Color fundus image — 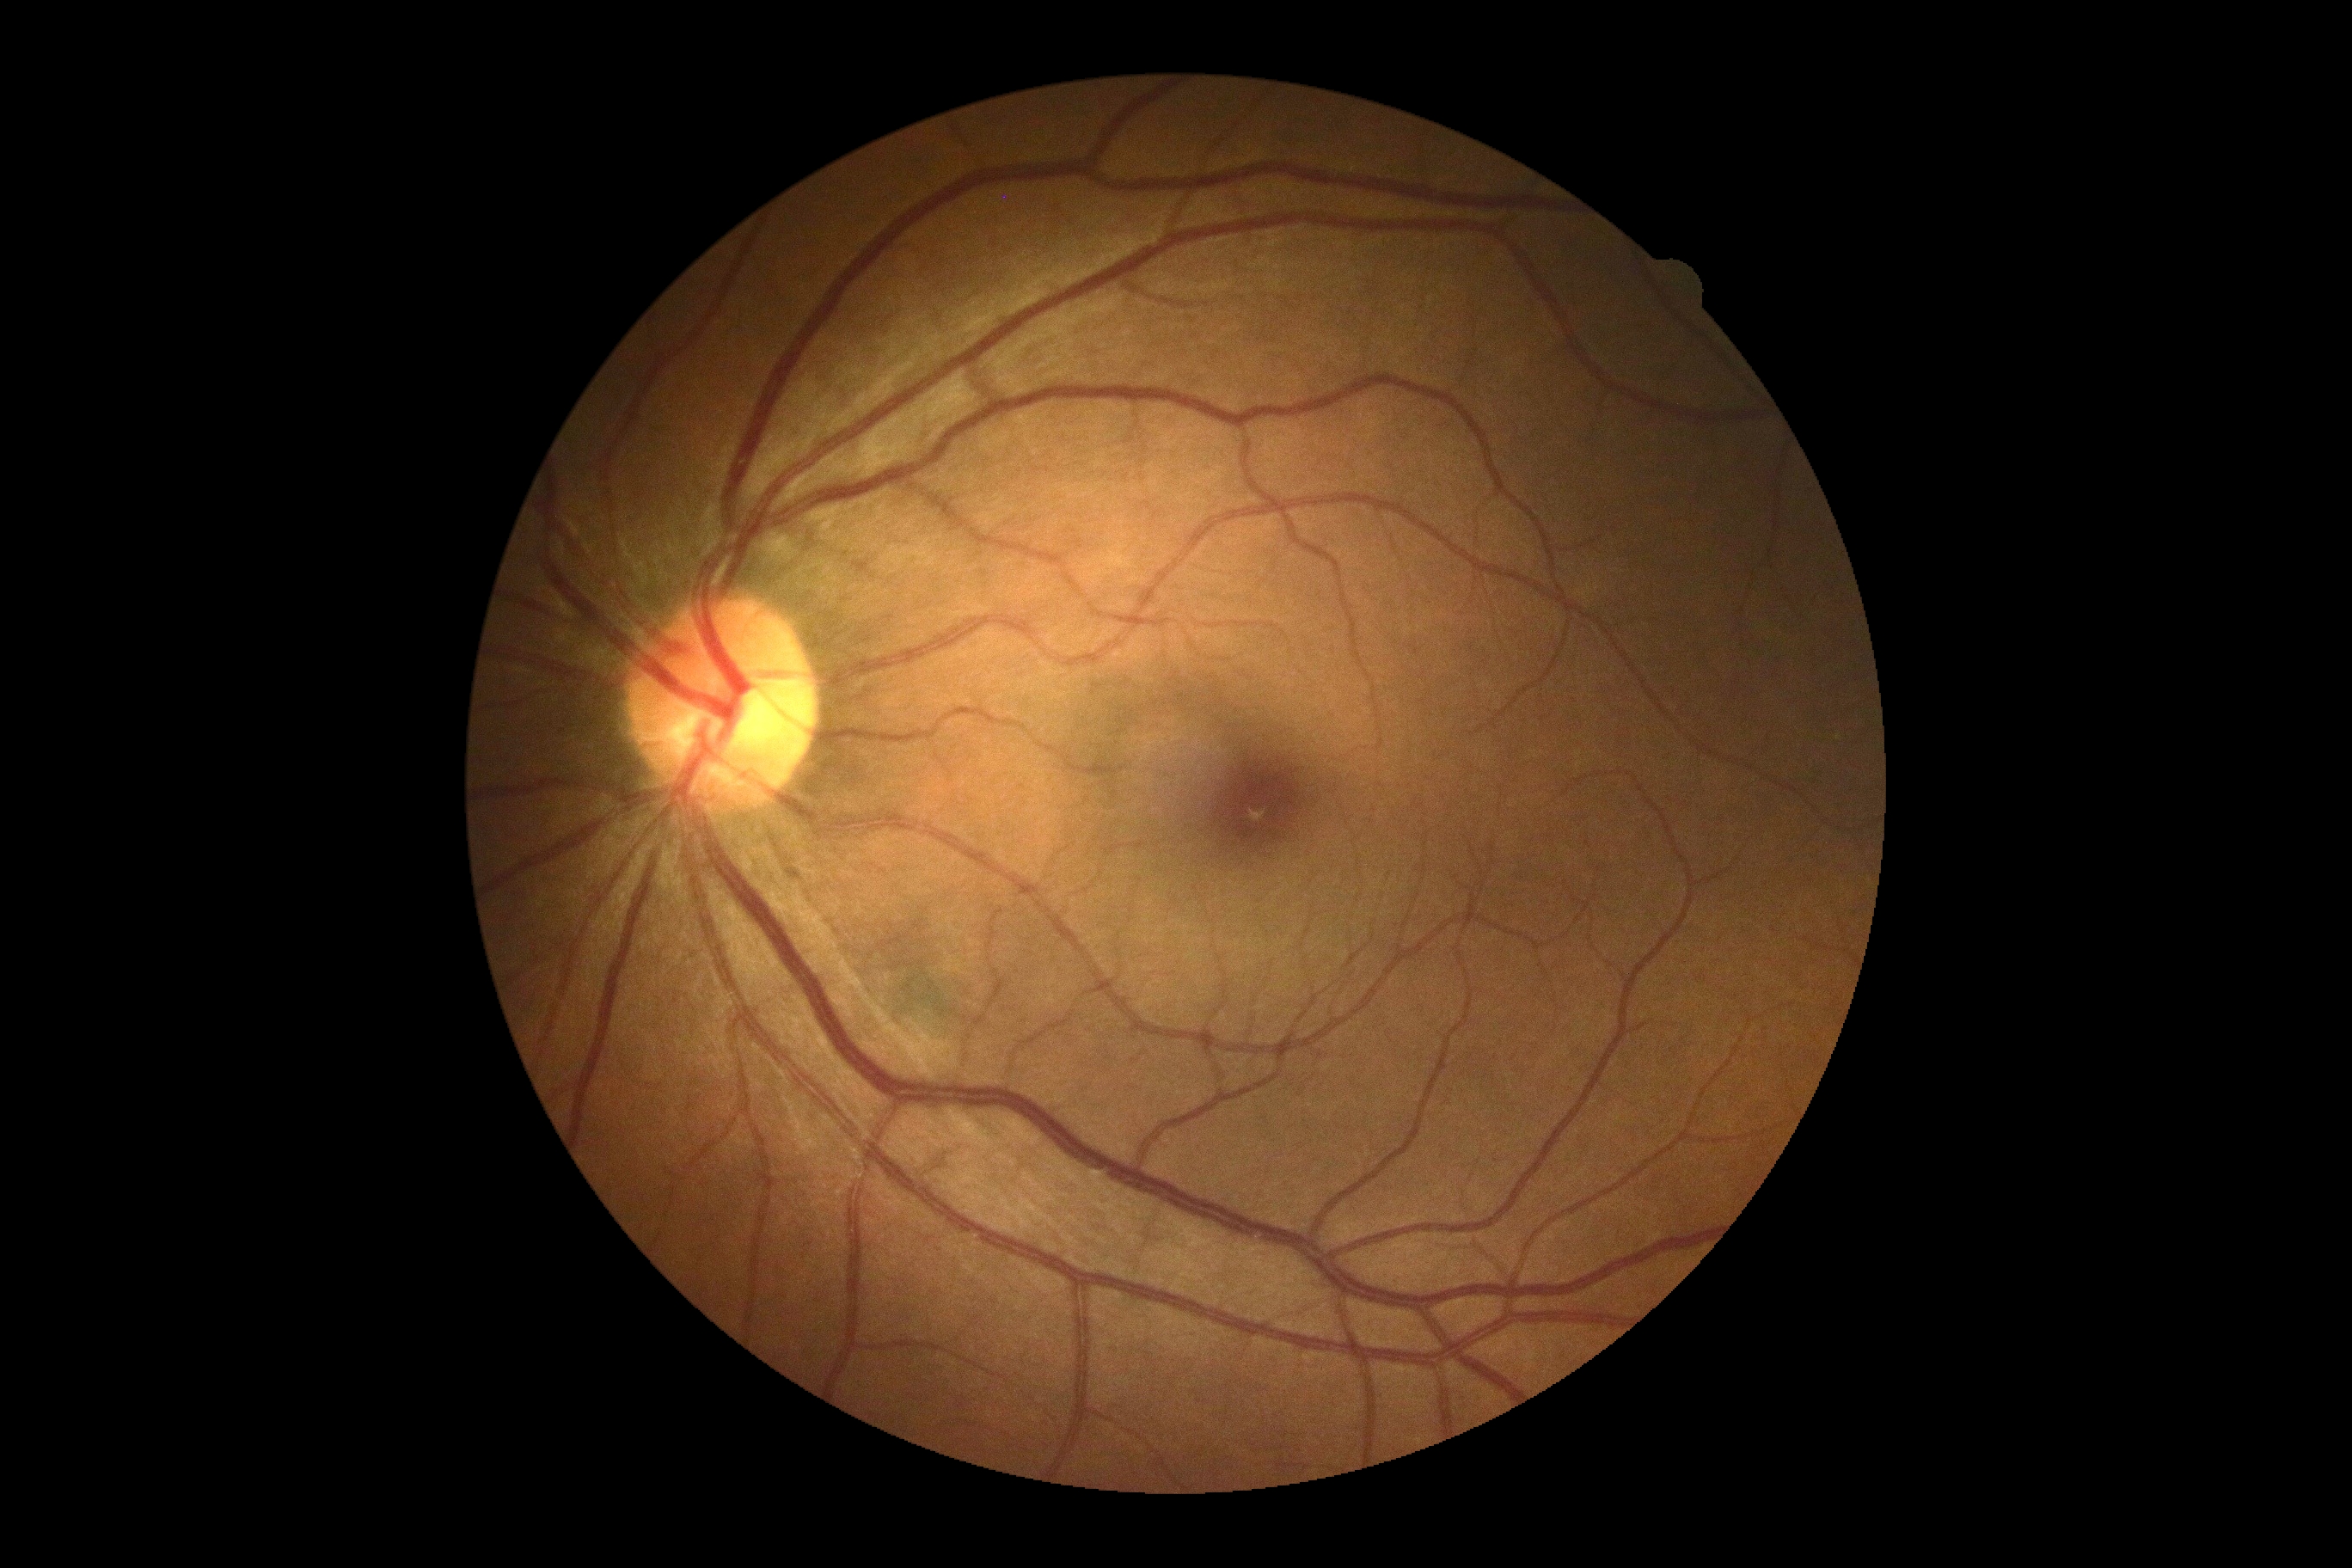

DR impression = negative for DR
diabetic retinopathy grade = 0